Wide-field fundus image from infant ROP screening; camera: Clarity RetCam 3 (130° FOV):
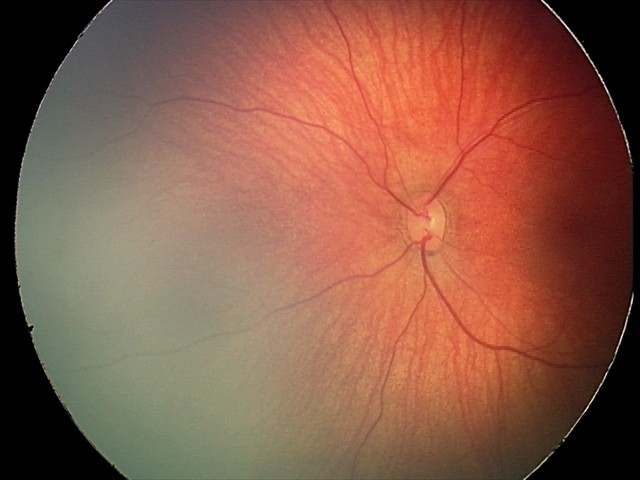
Q: What was the screening finding?
A: retinal hemorrhages